Fundus image cropped to the optic disc:
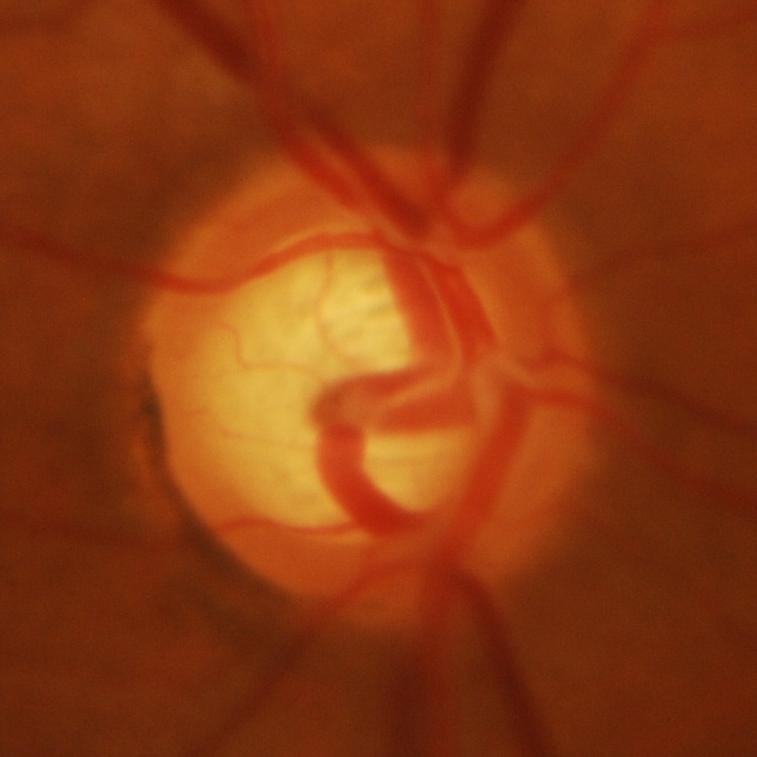
Glaucoma is present. Finding: glaucomatous findings.